NIDEK AFC-230
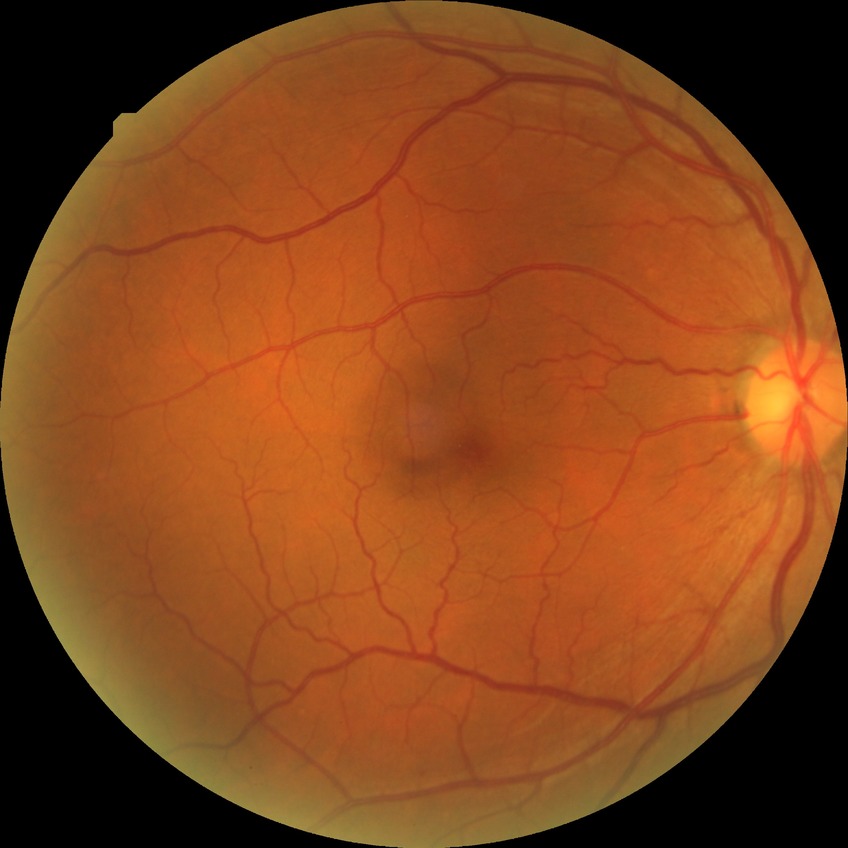
Diabetic retinopathy (DR) is no diabetic retinopathy (NDR).